1936x1296px. 45° FOV. Color fundus image.
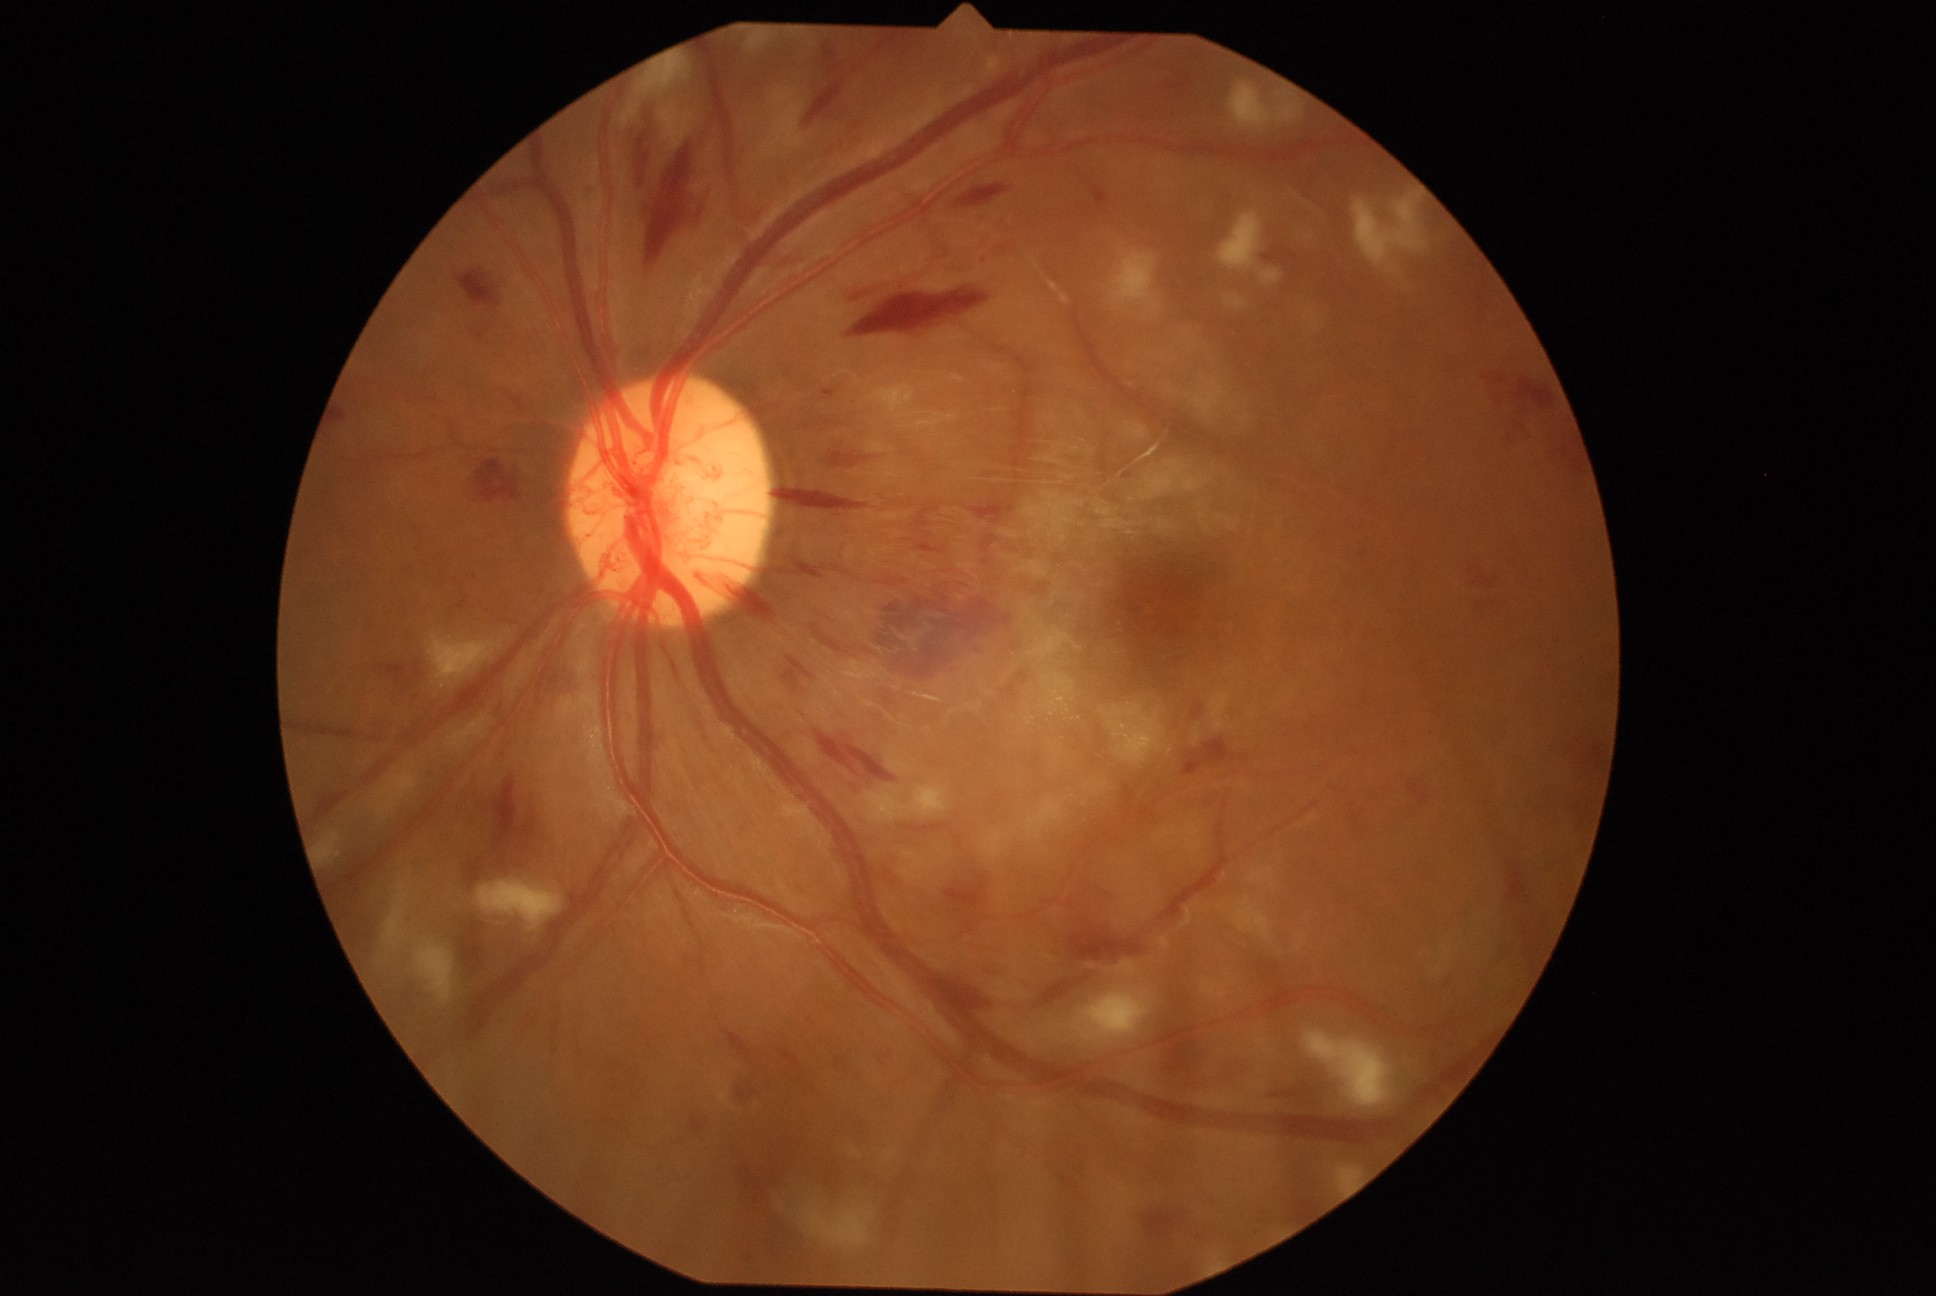 Diabetic retinopathy (DR) is PDR (grade 4); proliferative diabetic retinopathy. Hemorrhages (HEs) (partial list) at bbox=[1513, 419, 1535, 437] | bbox=[698, 573, 716, 588] | bbox=[1070, 928, 1145, 962] | bbox=[1407, 782, 1430, 806] | bbox=[823, 42, 841, 75] | bbox=[1000, 672, 1028, 702] | bbox=[945, 884, 985, 910] | bbox=[472, 460, 523, 500] | bbox=[916, 542, 946, 553] | bbox=[1472, 597, 1499, 614] | bbox=[646, 145, 694, 268] | bbox=[508, 392, 516, 402] | bbox=[1469, 568, 1474, 577] | bbox=[1597, 743, 1606, 765] | bbox=[805, 84, 842, 126] | bbox=[957, 186, 1012, 209] | bbox=[823, 389, 836, 398].